Fundus photograph cropped around the optic nerve head:
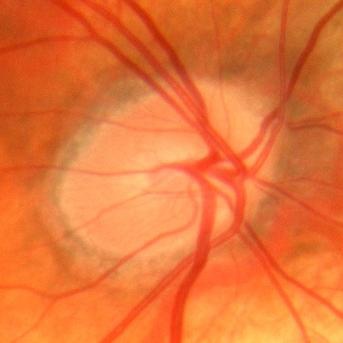 Showing no glaucomatous changes.